Camera: Clarity RetCam 3 (130° FOV); RetCam wide-field infant fundus image; 640 by 480 pixels — 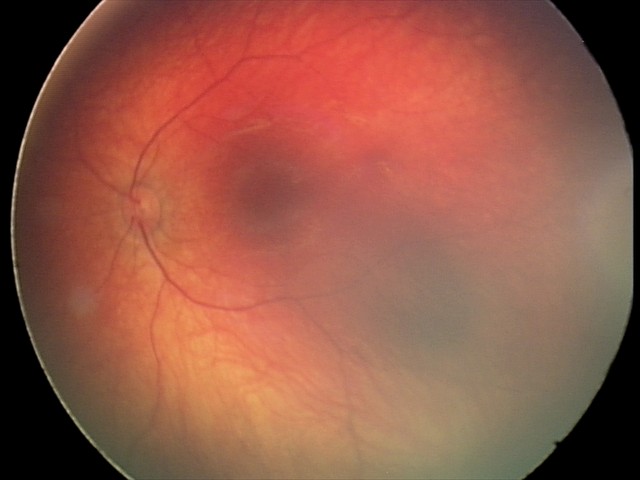
Series diagnosed as retinal hemorrhages.